ONH-centered crop from a color fundus image:
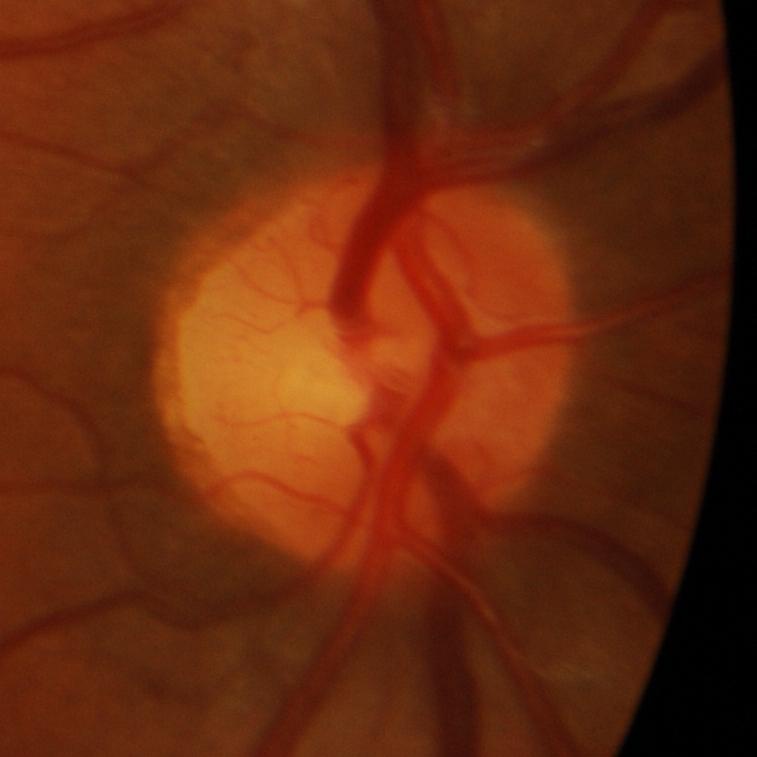

Glaucomatous changes are present. Showing glaucomatous optic neuropathy.